2212x1659, fundus photo, 45° FOV.
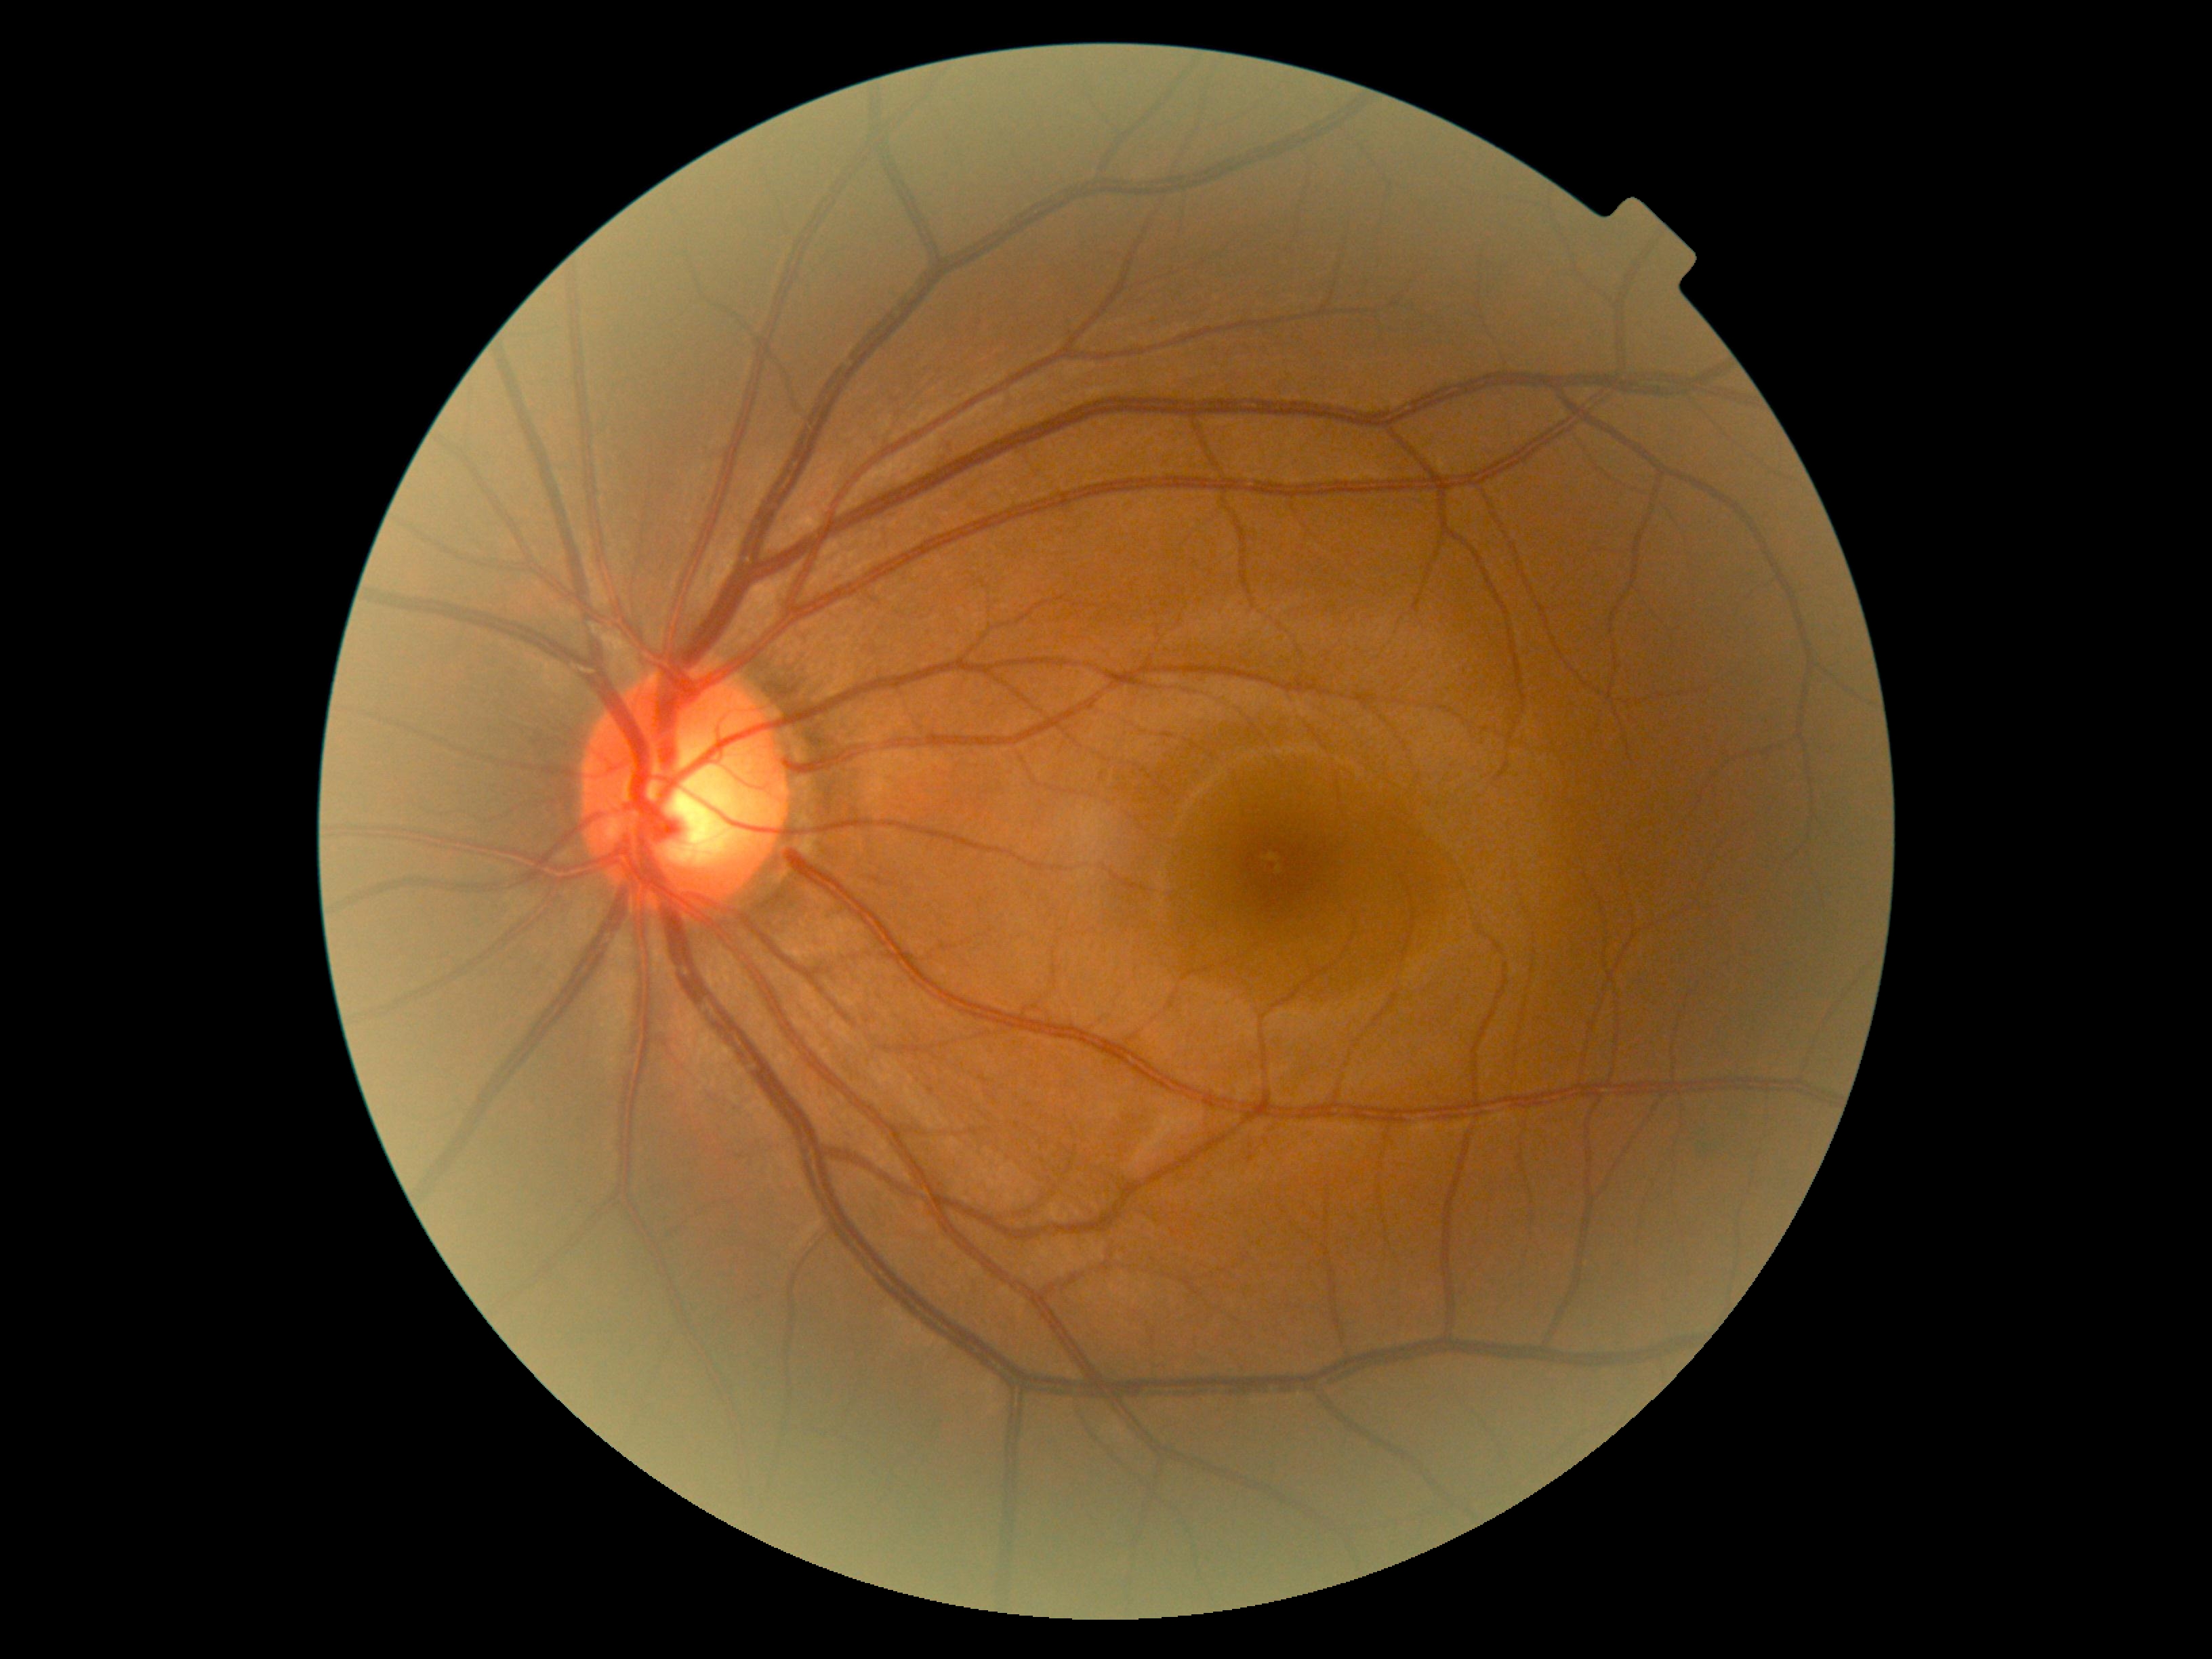

{"dr_grade": "0 (no apparent retinopathy)", "dr_impression": "negative for DR"}